1240x1240px · Phoenix ICON wide-field infant fundus image · 100° field of view (Phoenix ICON).
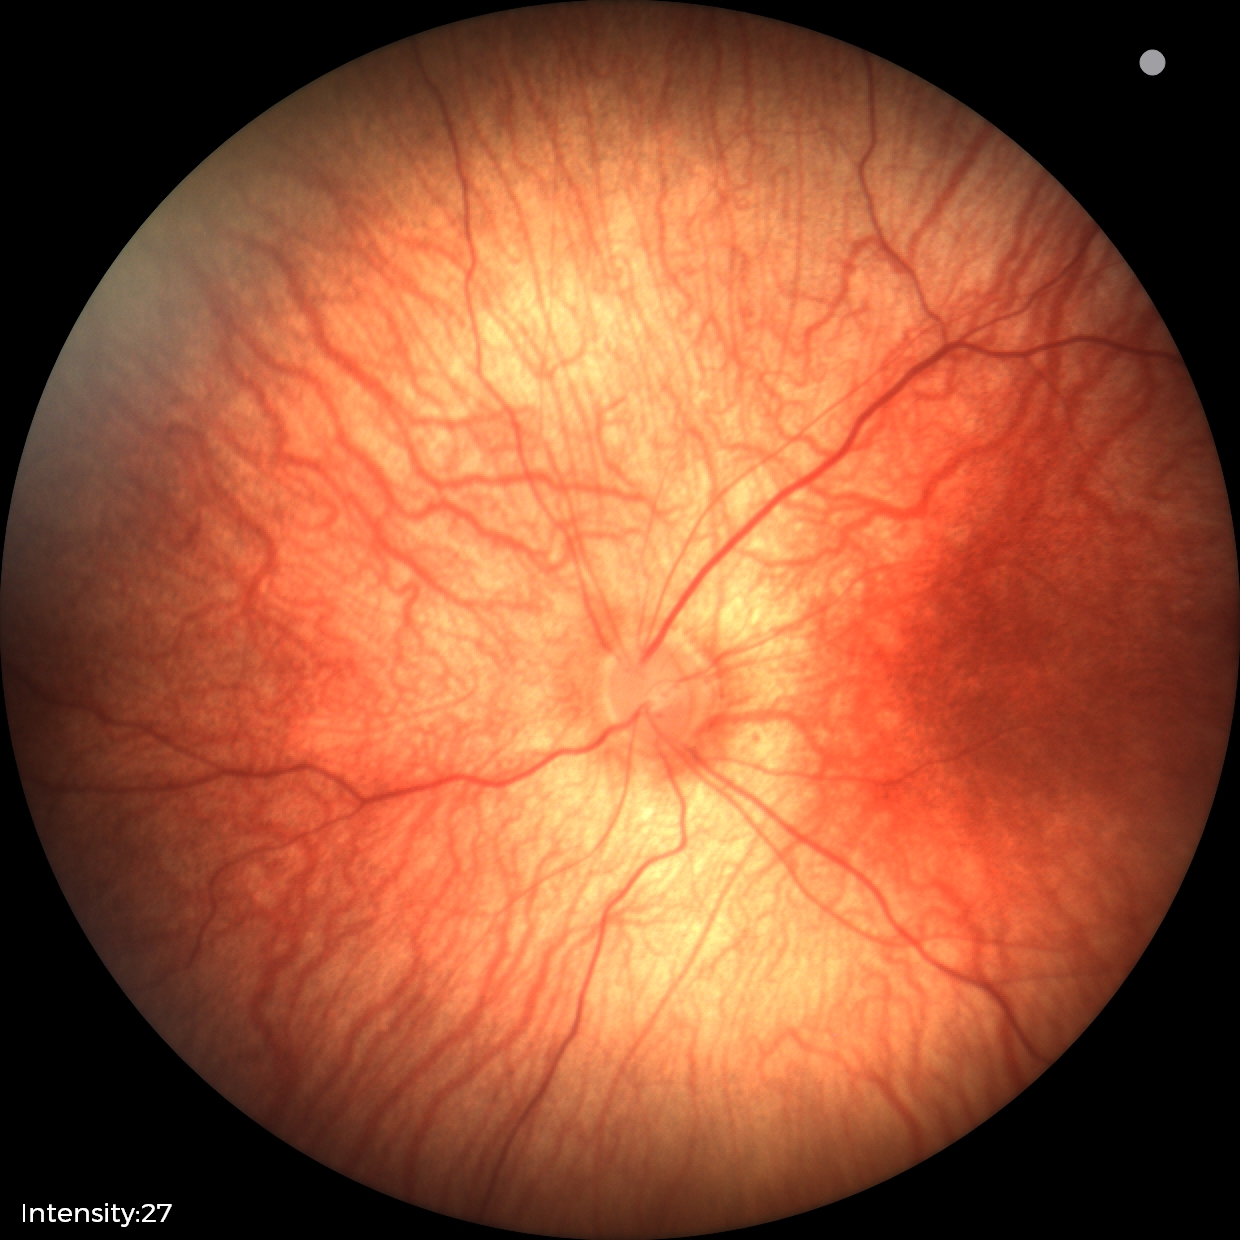
Finding = normal retinal appearance.